640x480px. Pediatric wide-field fundus photograph. 130° field of view (Clarity RetCam 3)
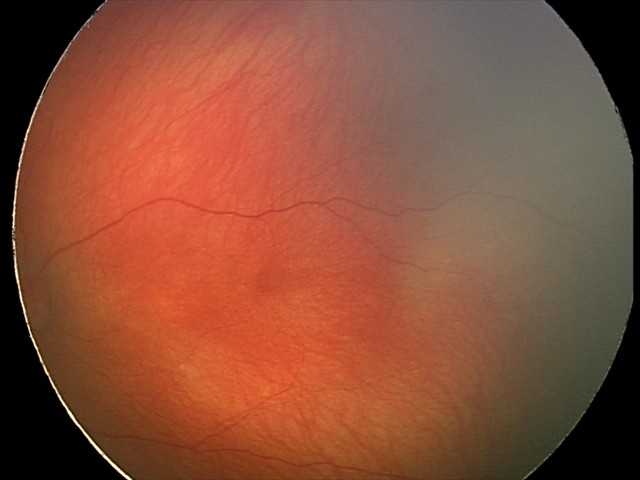
Physiological retinal appearance for postconceptual age.